Retinal fundus photograph
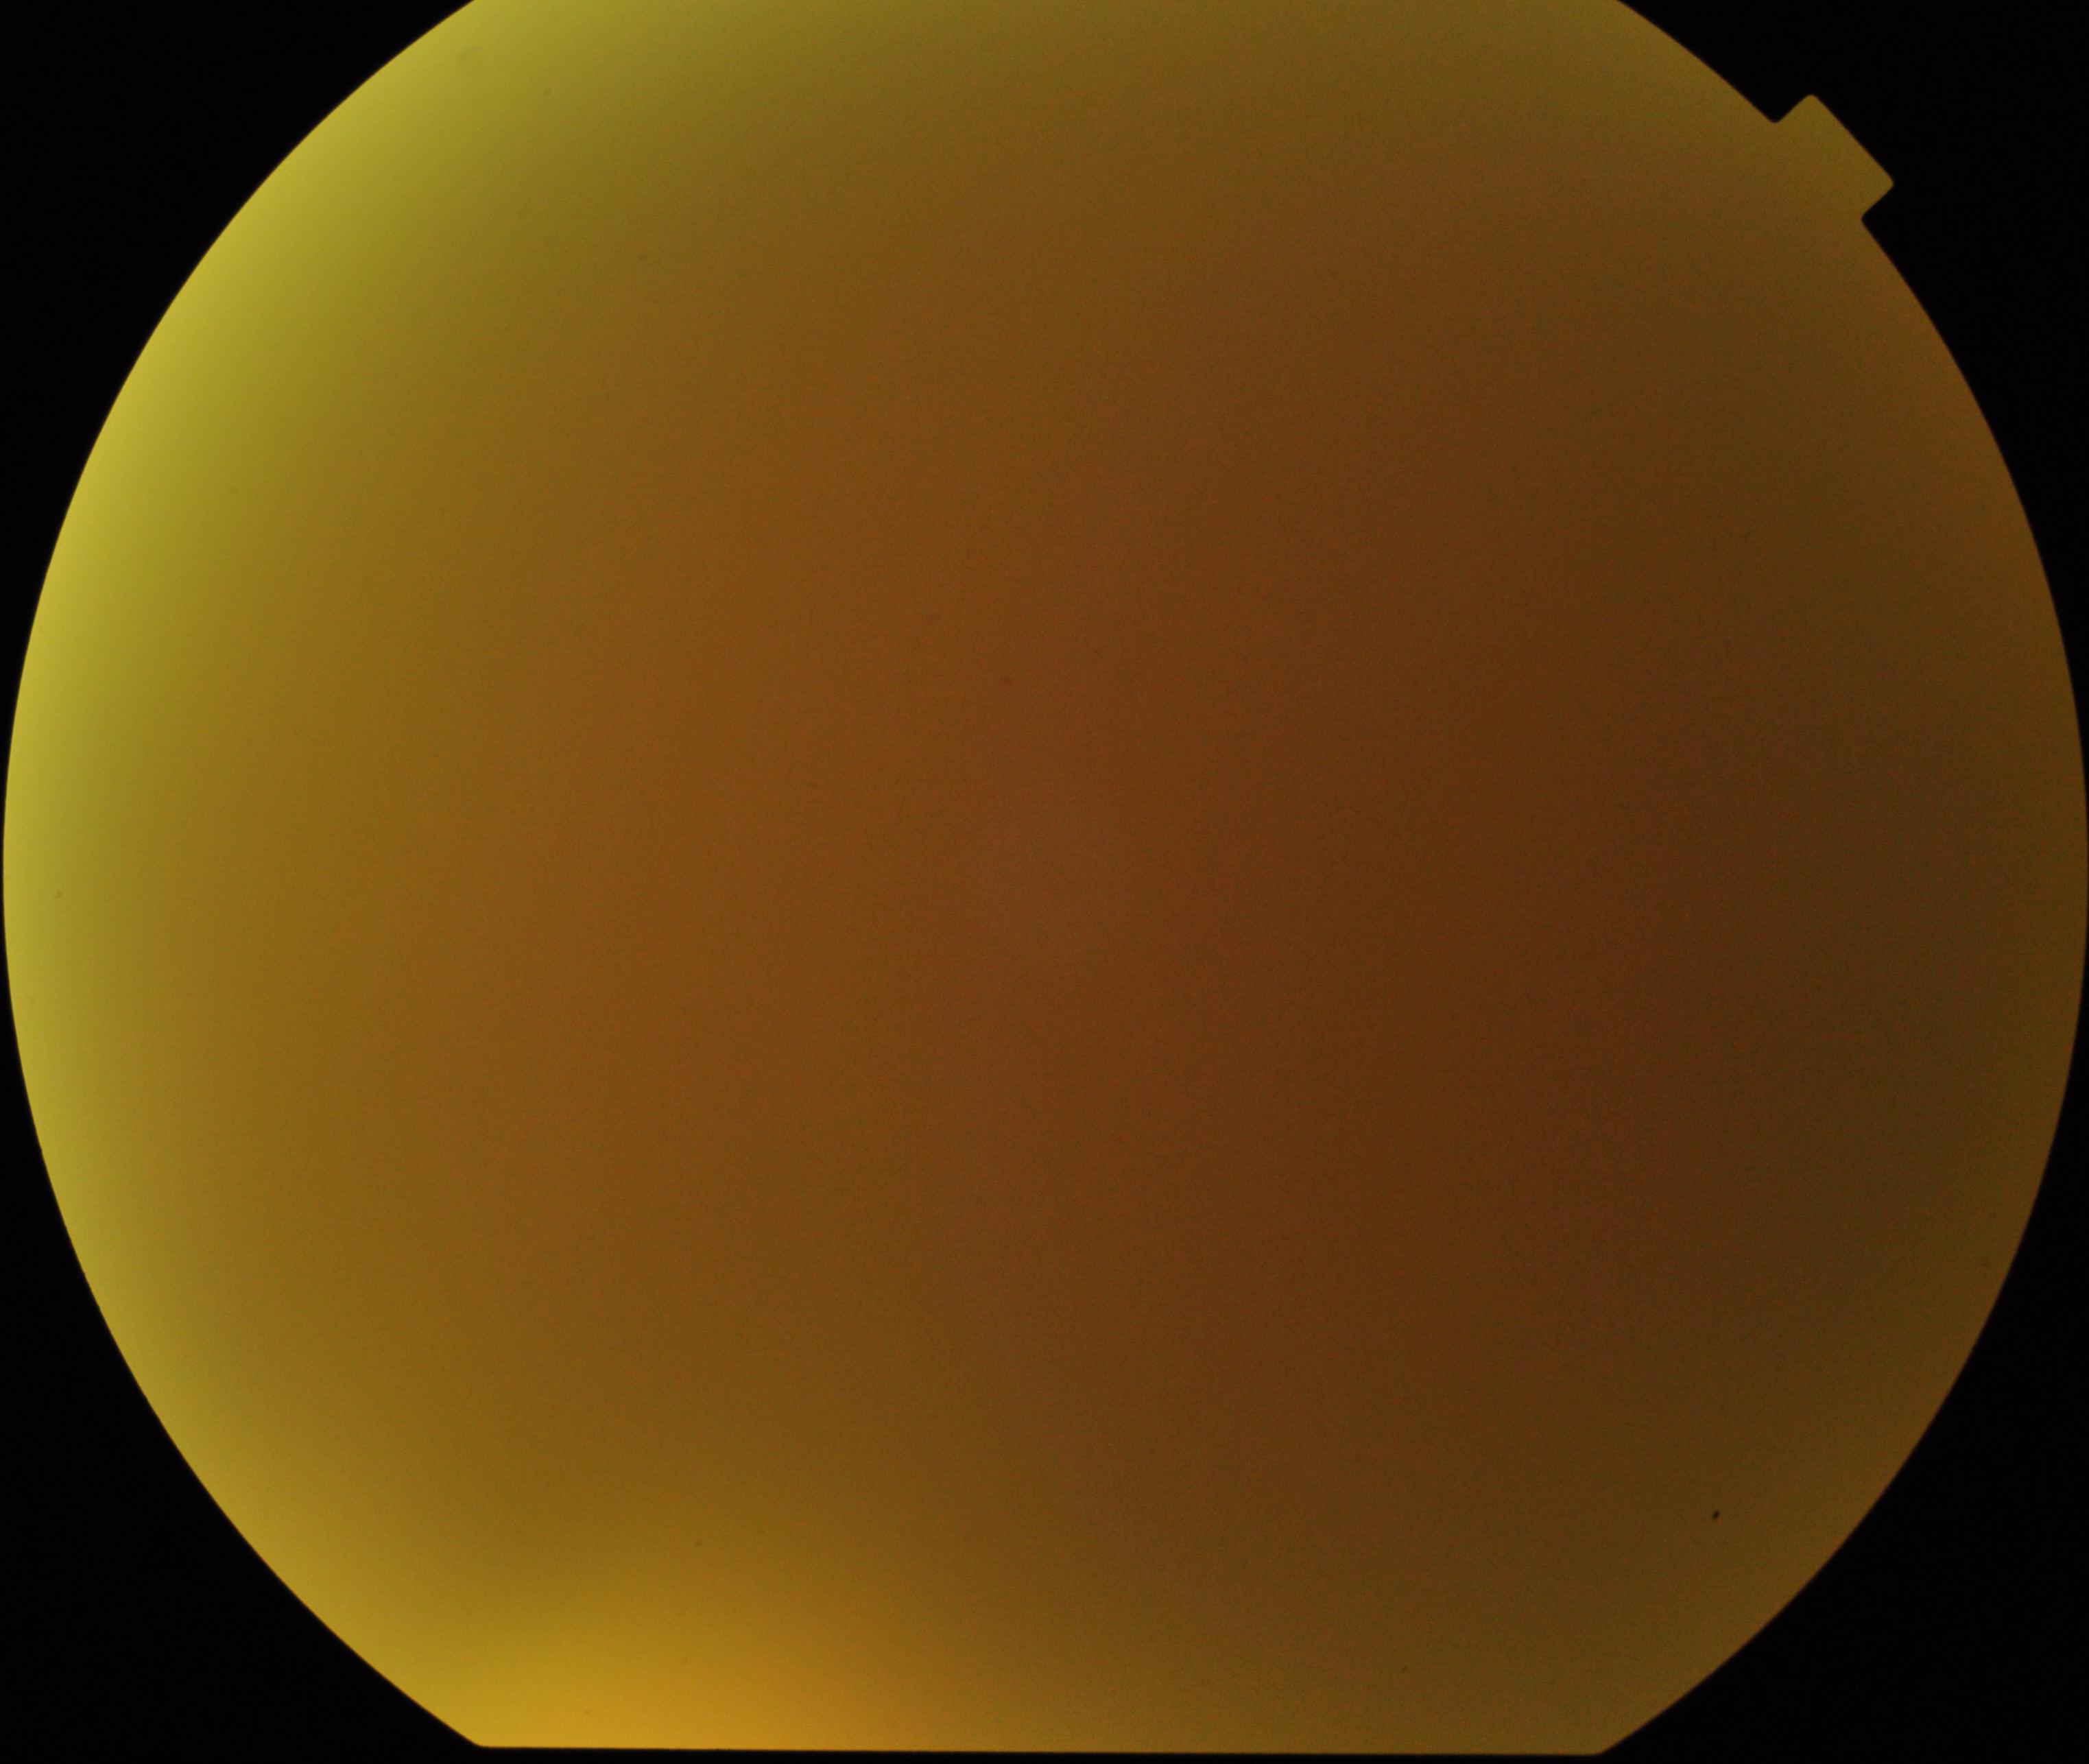

Image is blurred; retinal landmarks are largely obscured. Proliferative diabetic retinopathy not identified in the visible portion.